Optic disc region crop · non-mydriatic fundus camera — 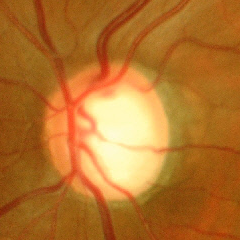 The image shows severe glaucomatous damage.